1440x1080px. Wide-field contact fundus photograph of an infant. Camera: Natus RetCam Envision (130° FOV).
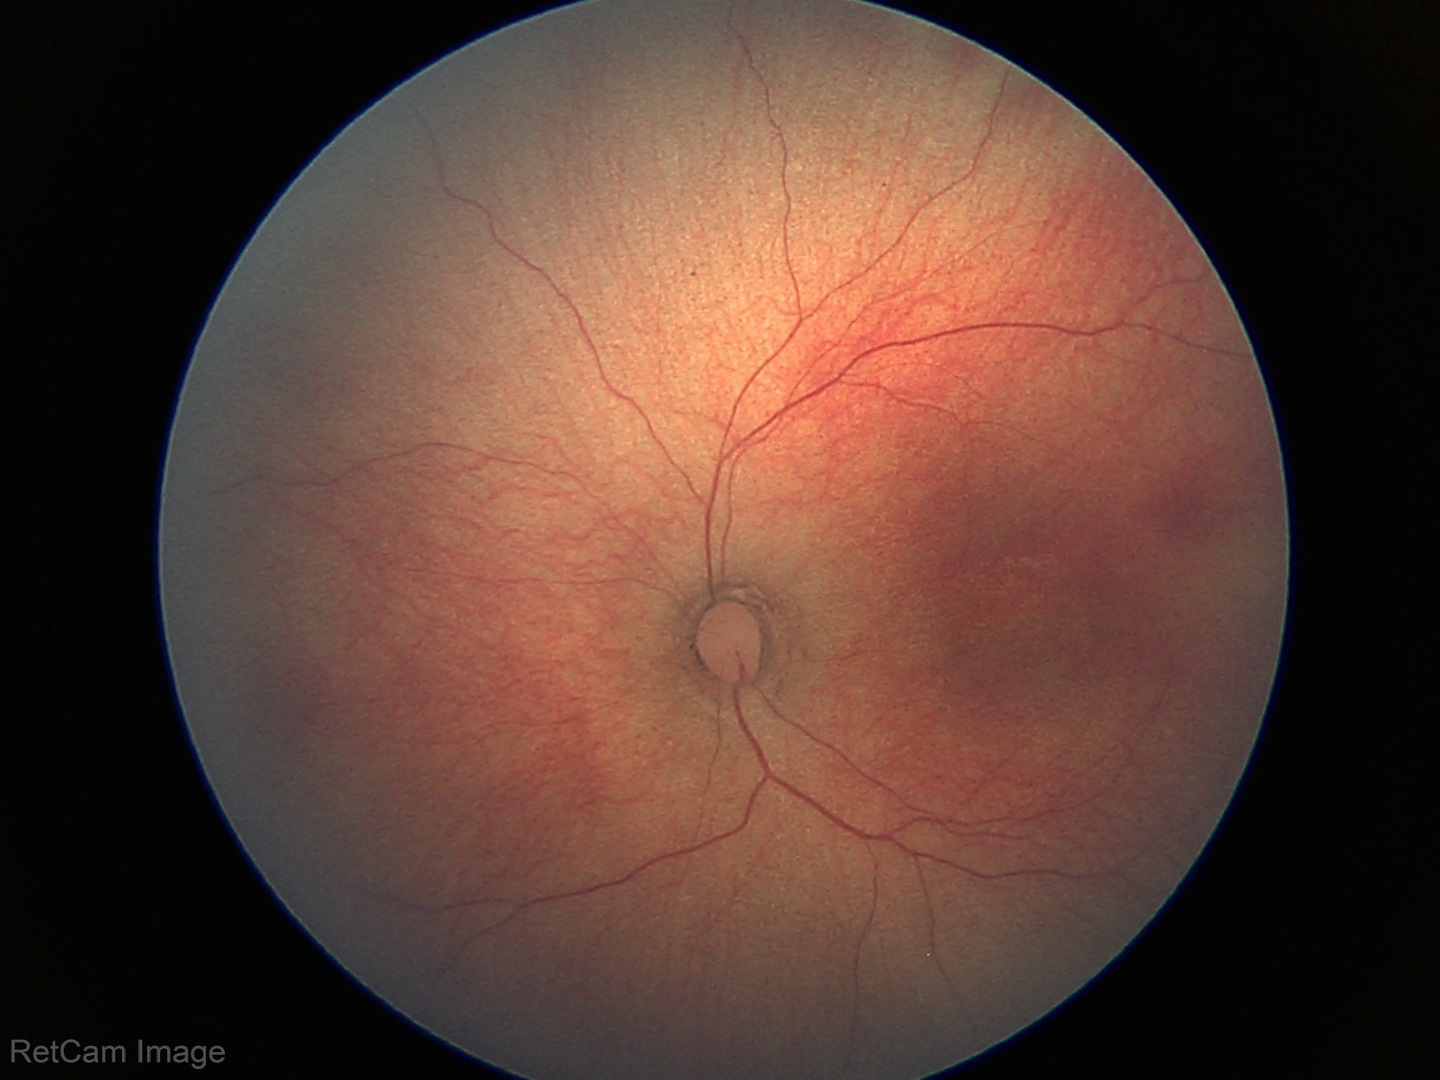
Screening: physiological retinal finding.